Axial length (AL): 22.85 mm · sex: female · pachymetry 495 µm · refraction: +2.25 -1.75 × 98° · patient age: 70 years
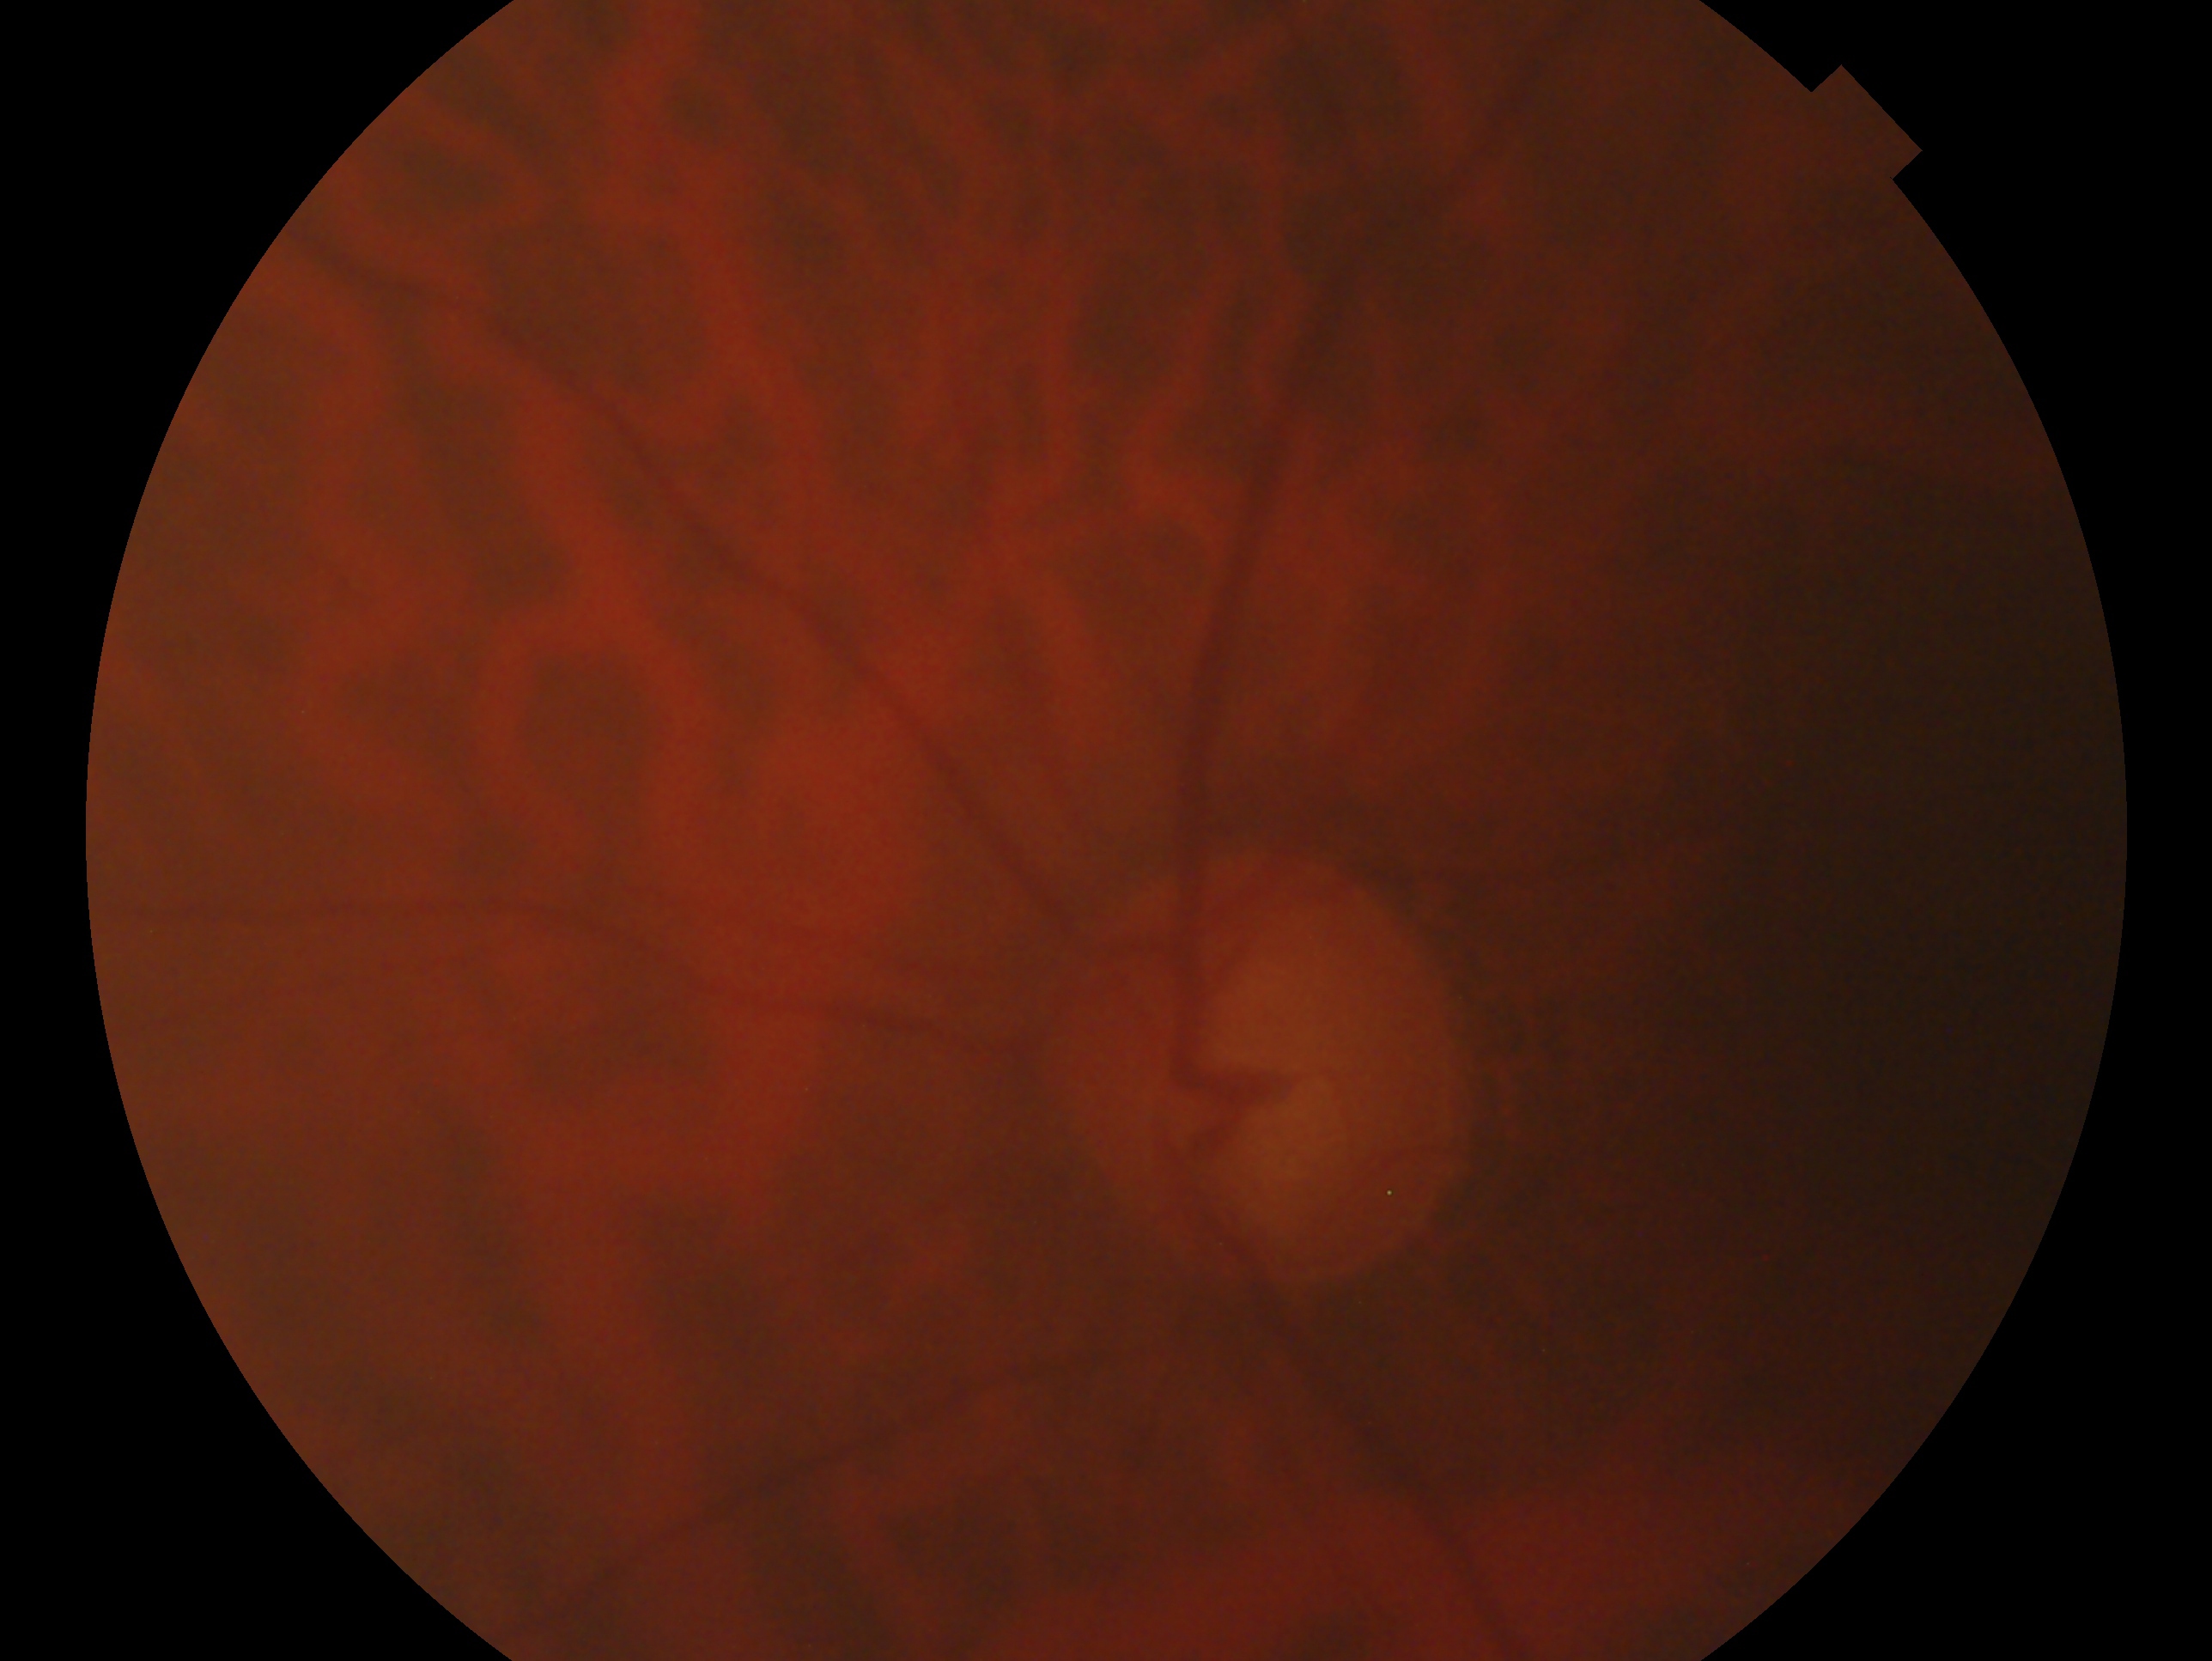

This is the left eye.
Diagnosis — glaucoma.